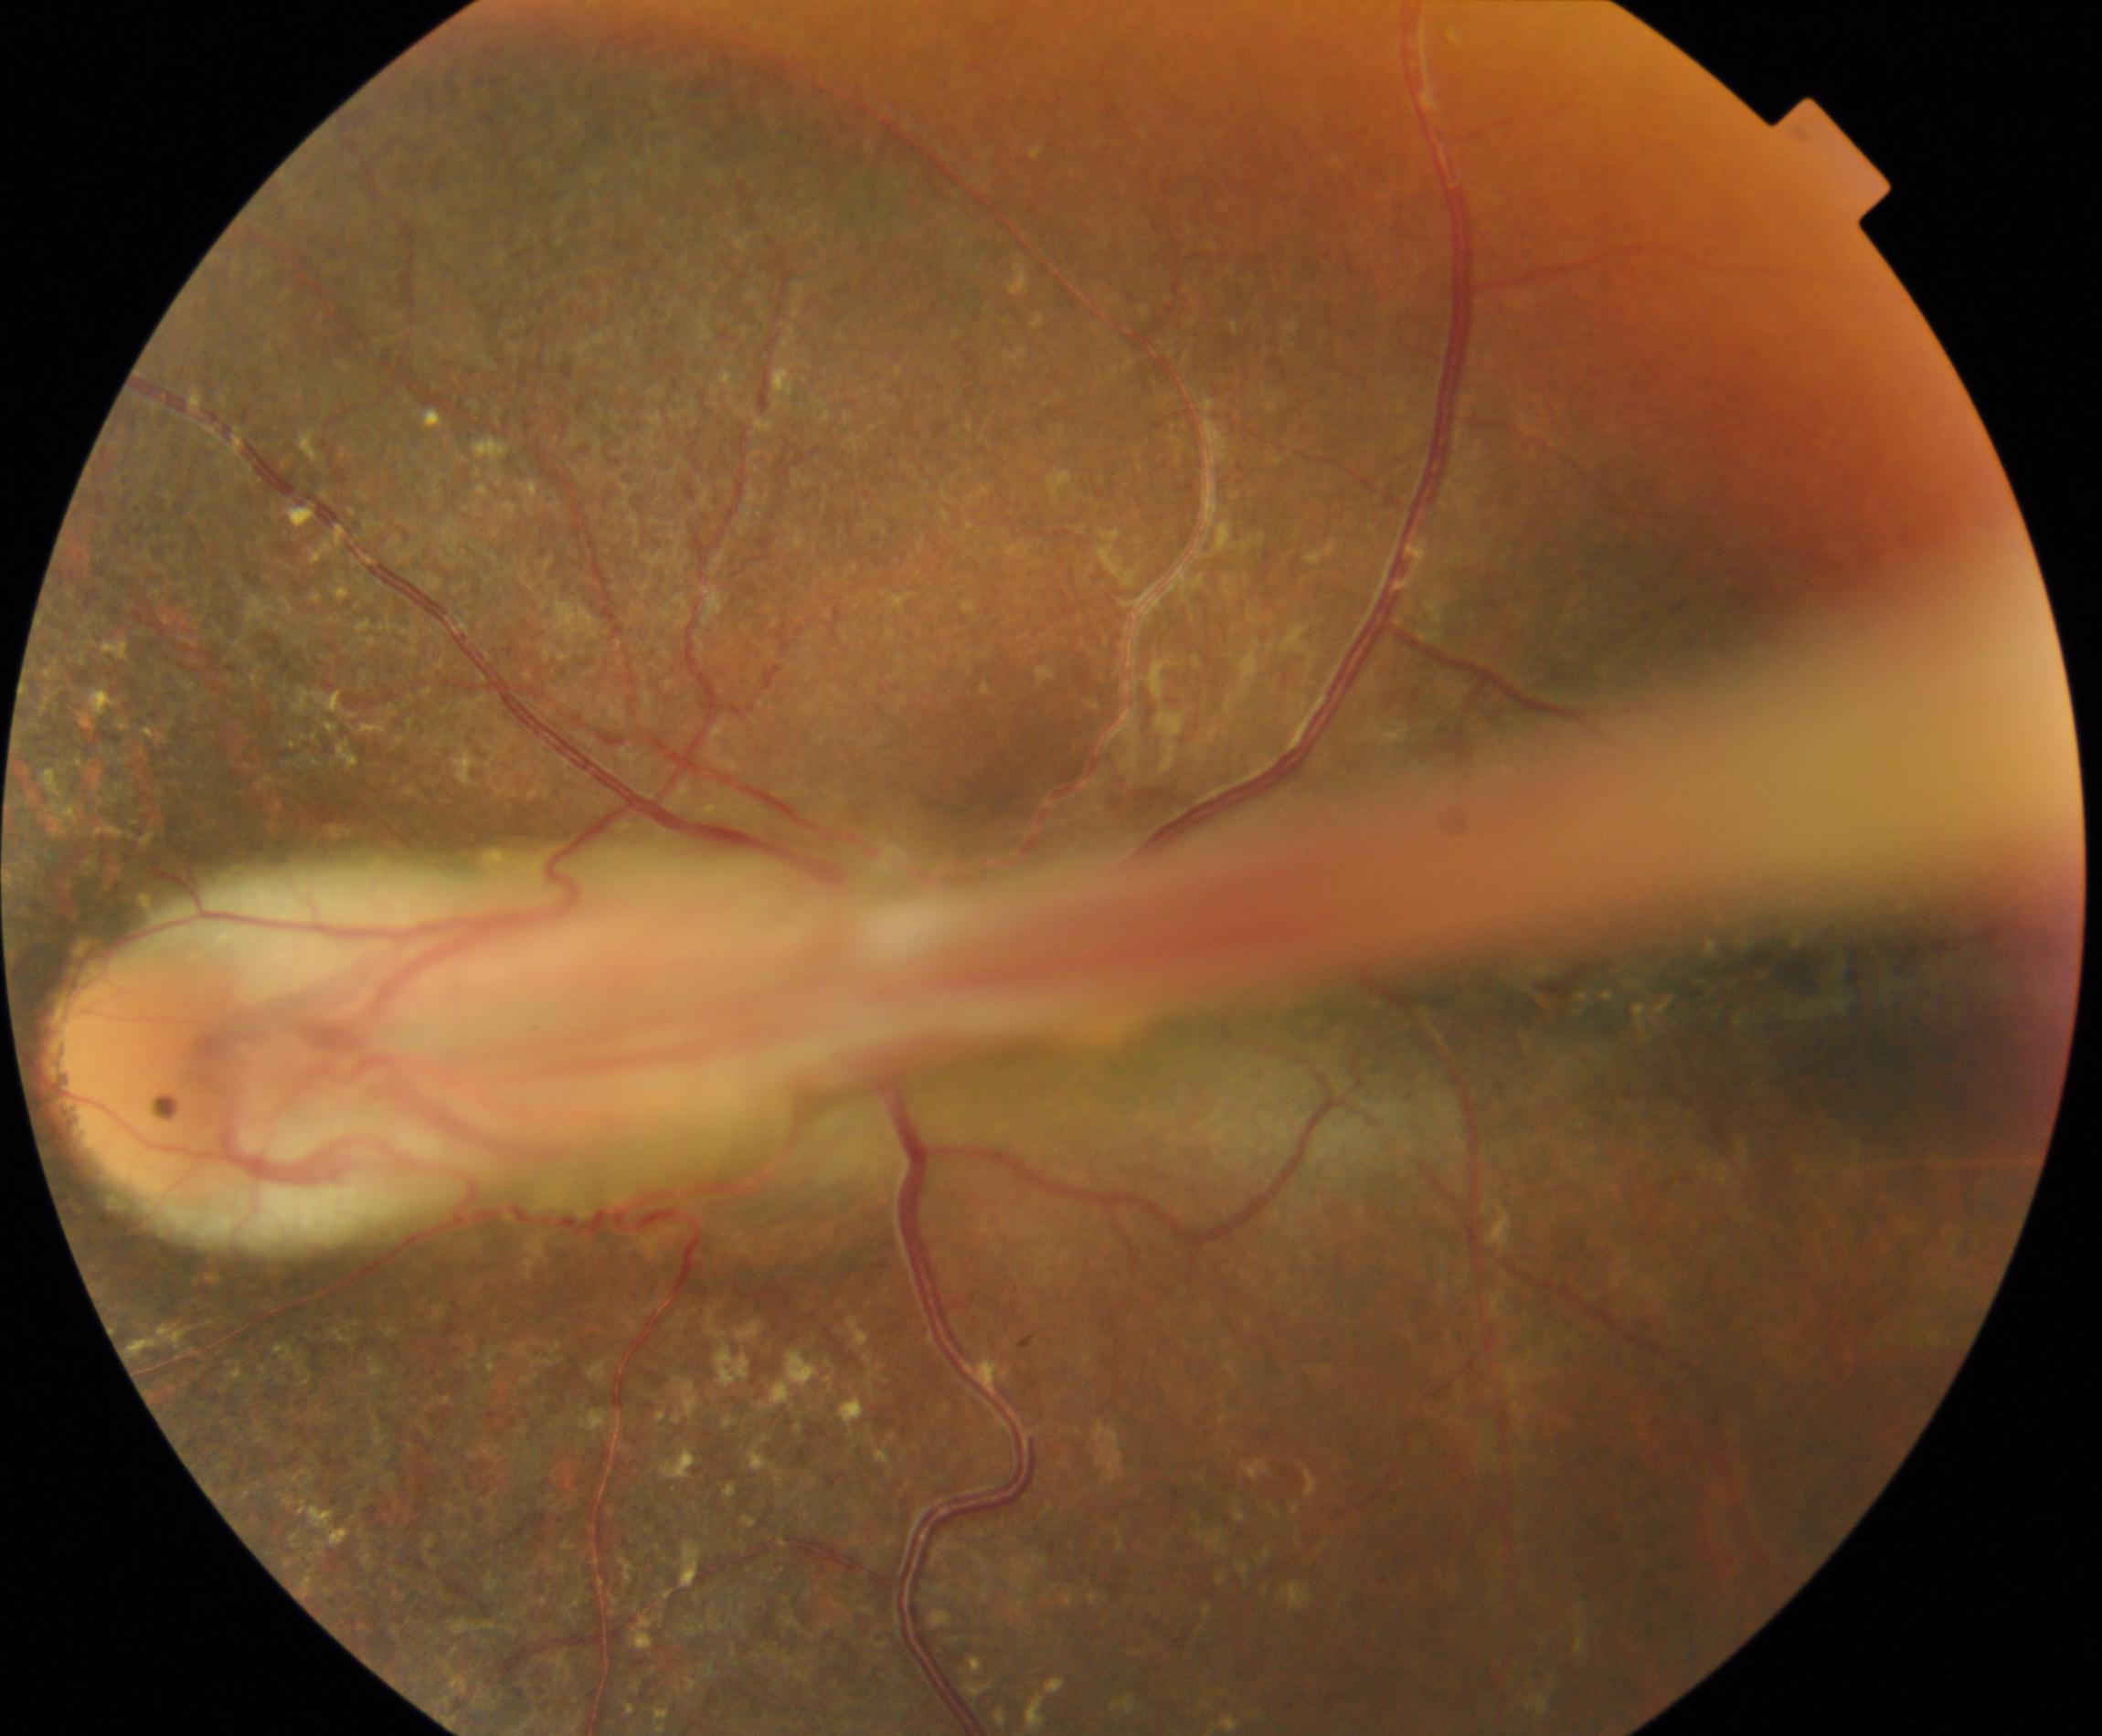
Findings: dragged disc. Typically showing temporal vascular straightening, retinal fold, or vitreous bands extending from the peripheral retina to the disc.